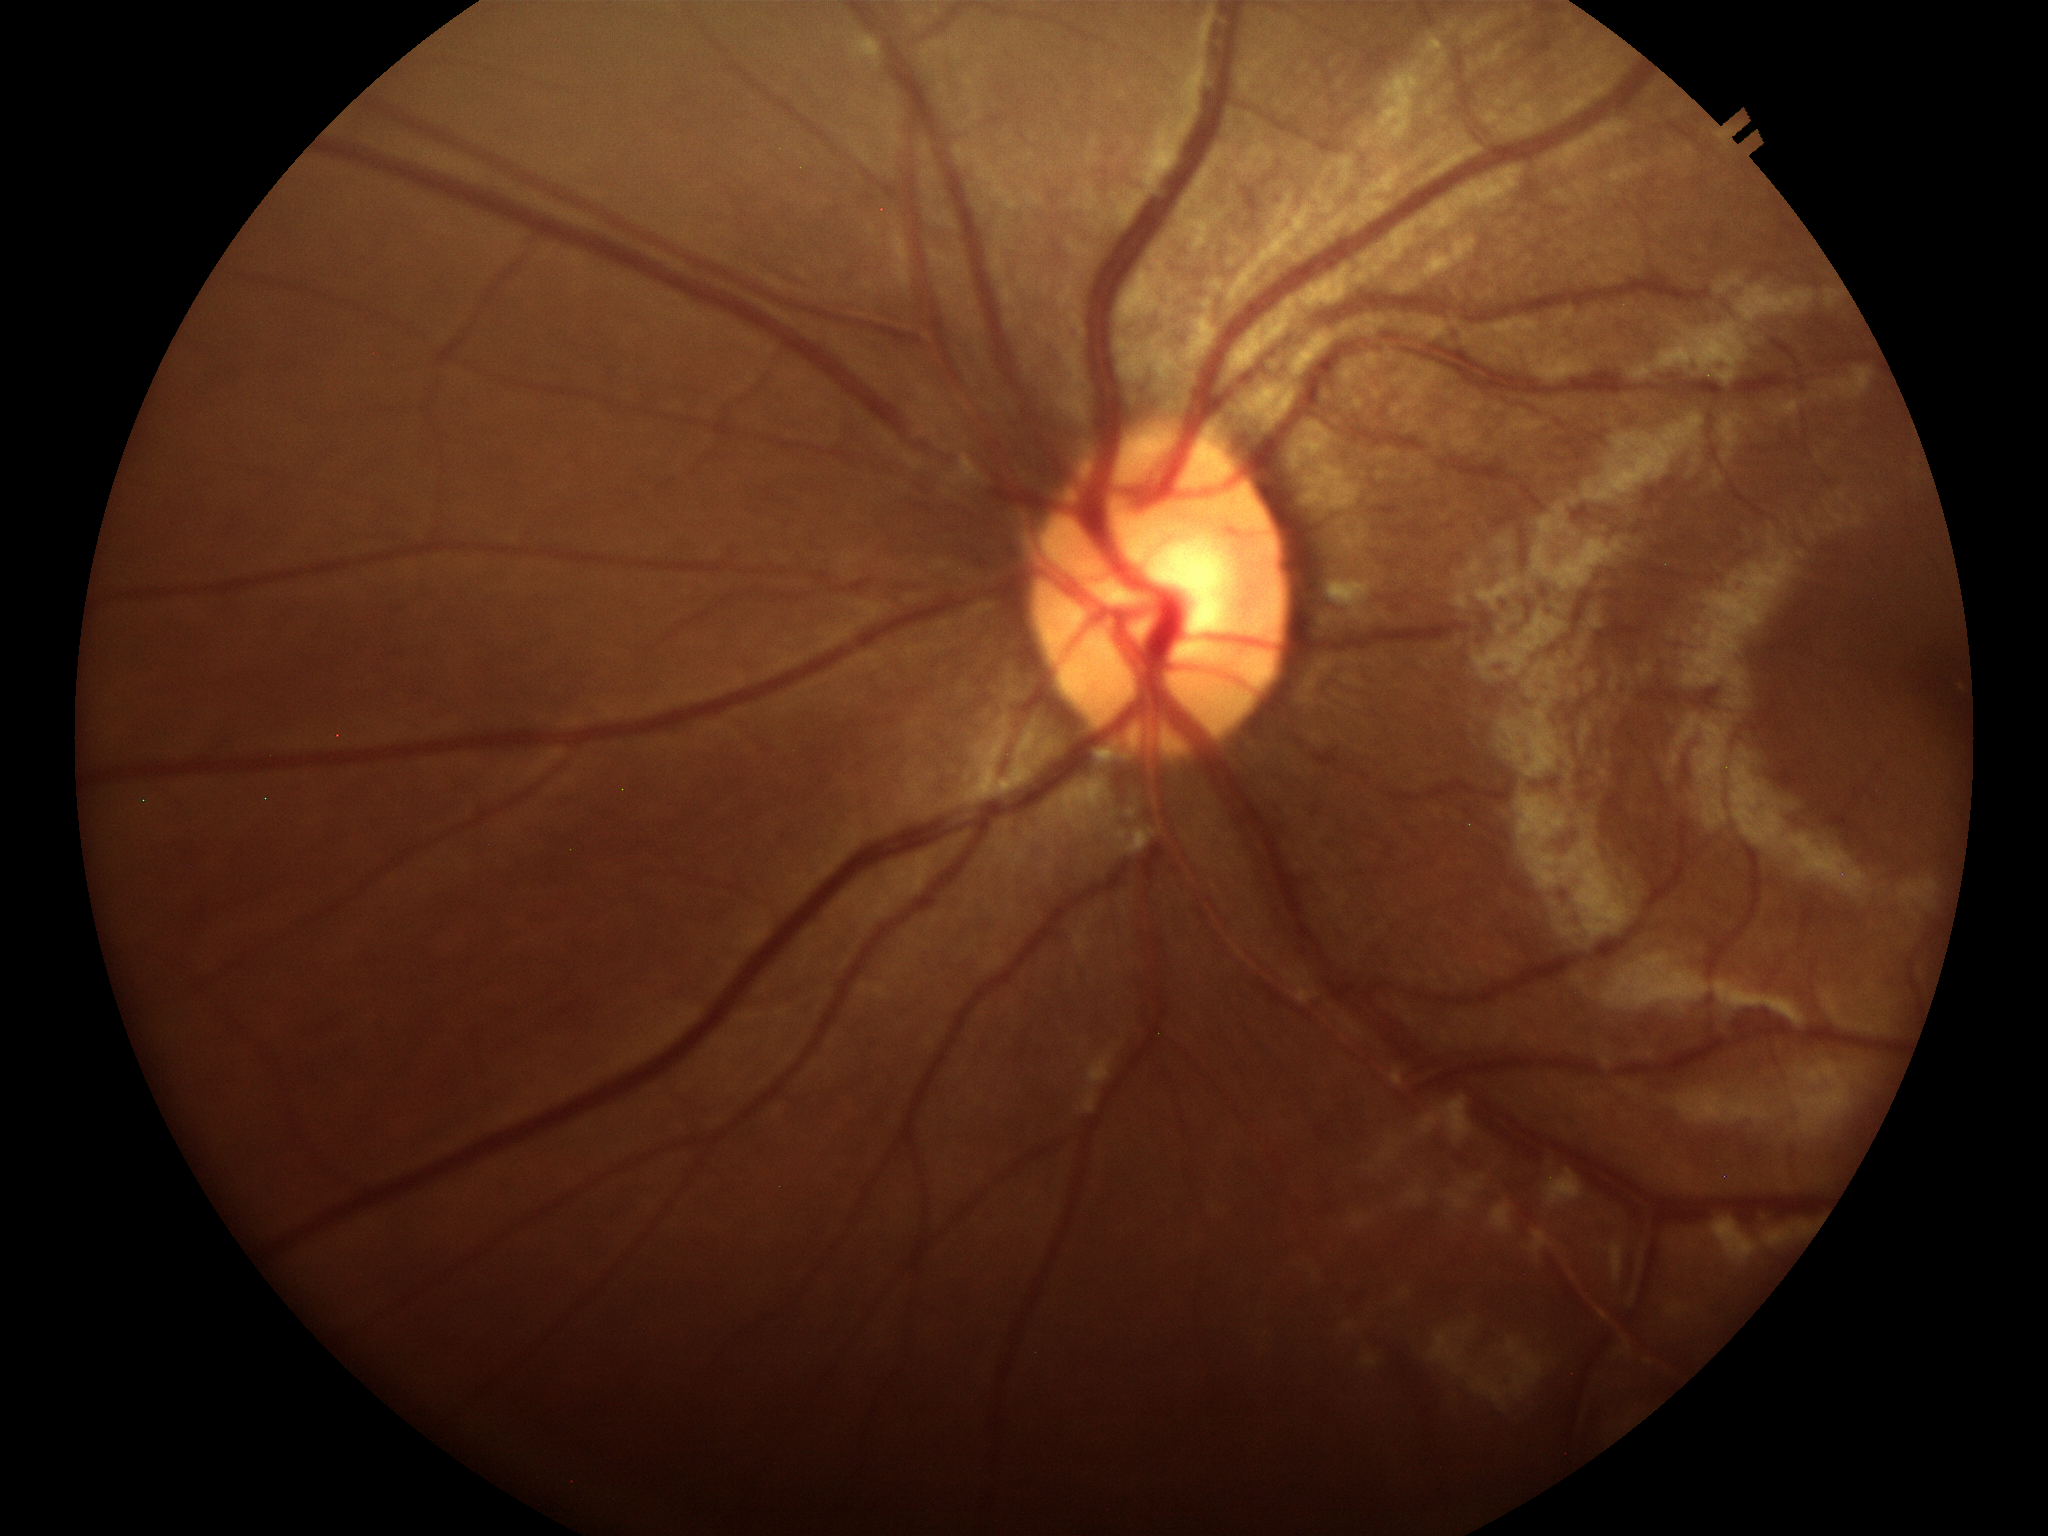 Glaucoma screening: no suspicious findings.
HCDR is 0.51.
VCDR: 0.51.